Image size 2361x1568. Retinal fundus photograph.
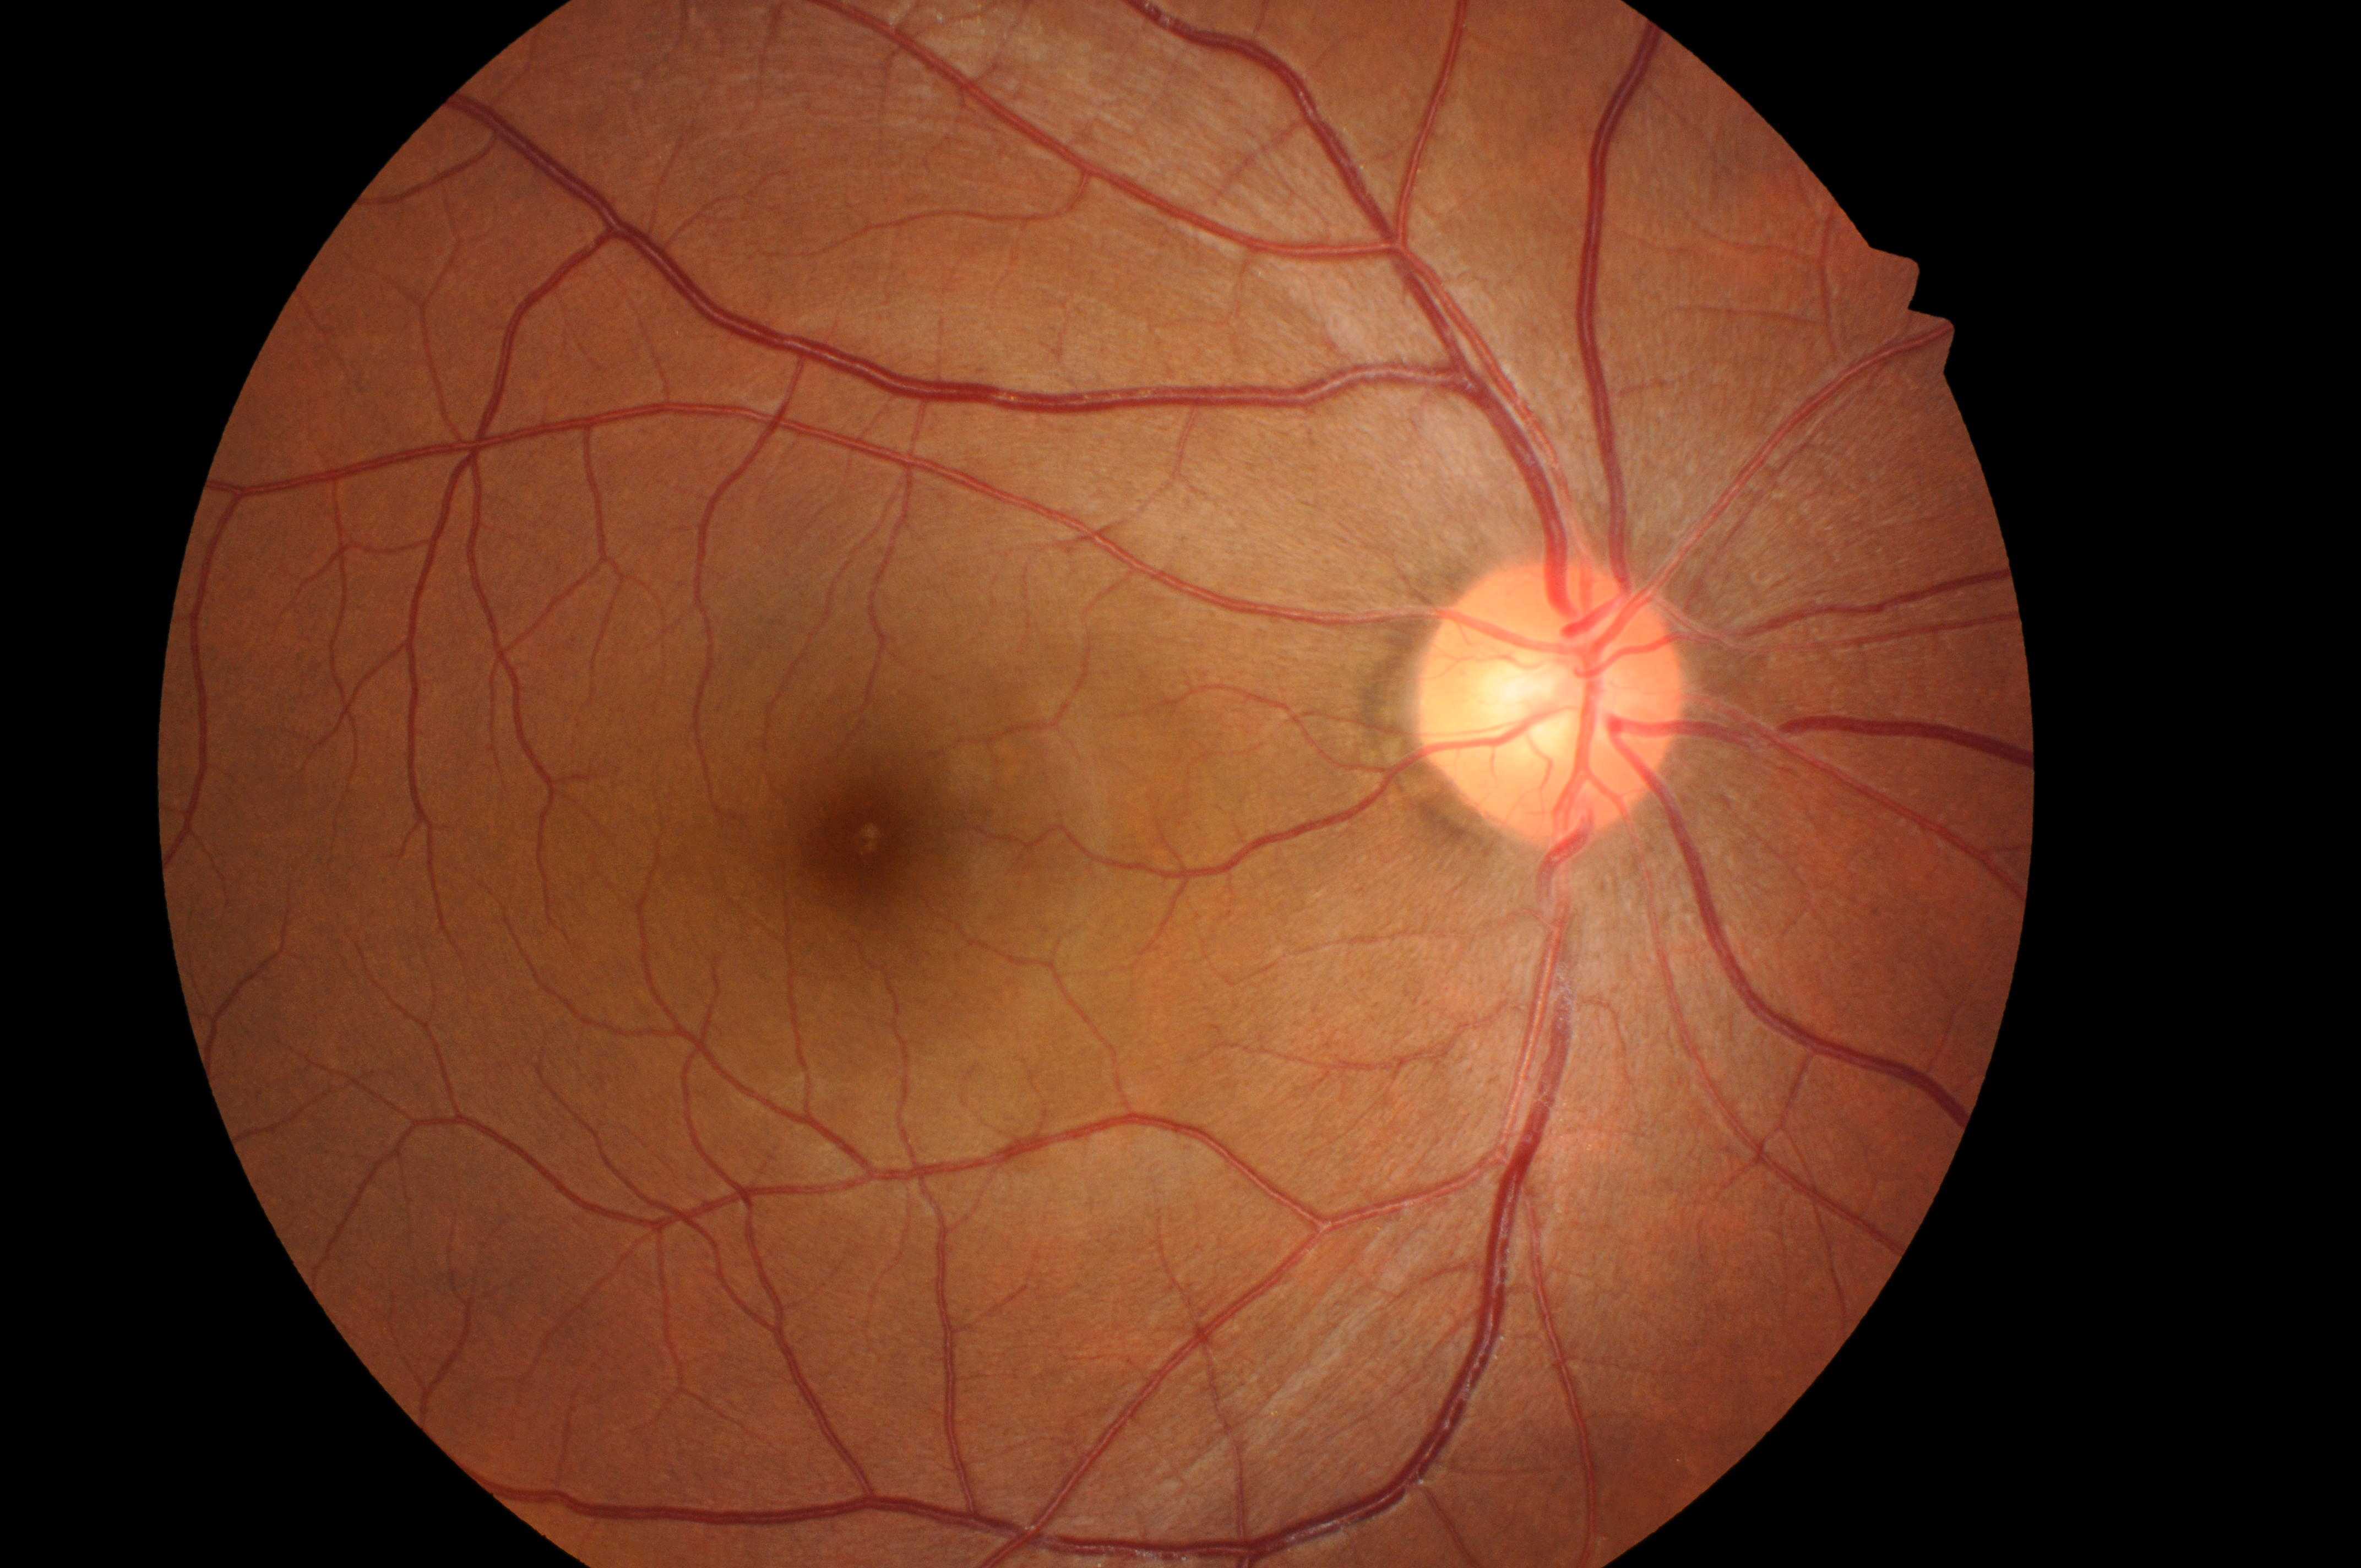
{"dme_grade": "no risk (grade 0)", "dr_grade": "0 (no apparent retinopathy)", "optic_disc": "1547px, 707px", "fovea": "864px, 843px", "eye": "OD"}